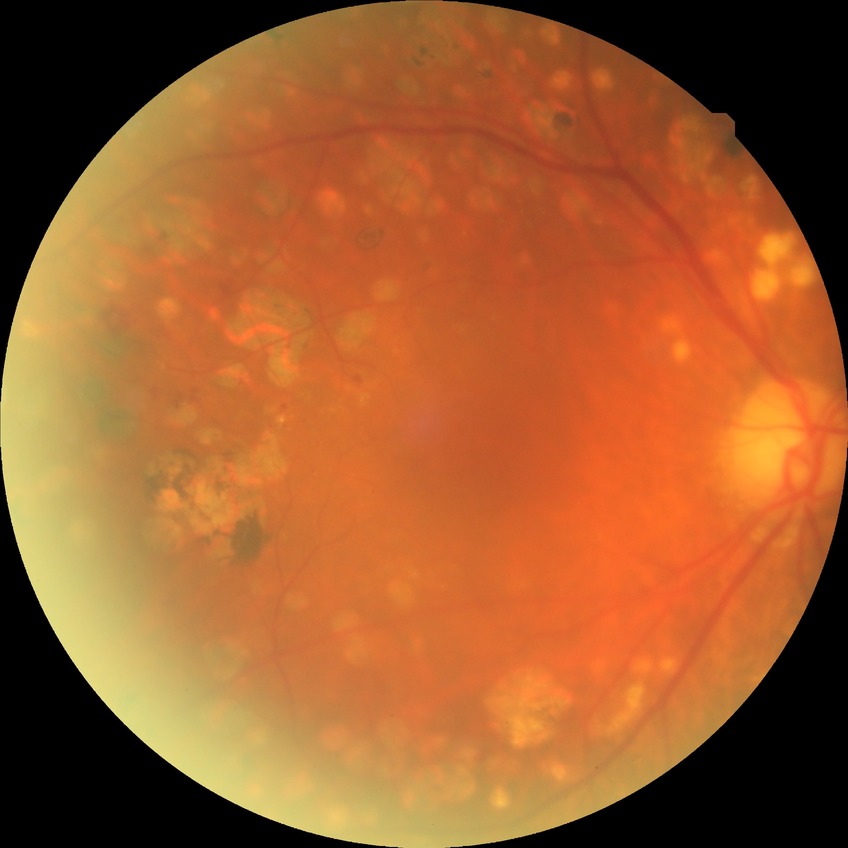 DR: PDR.